RetCam wide-field infant fundus image.
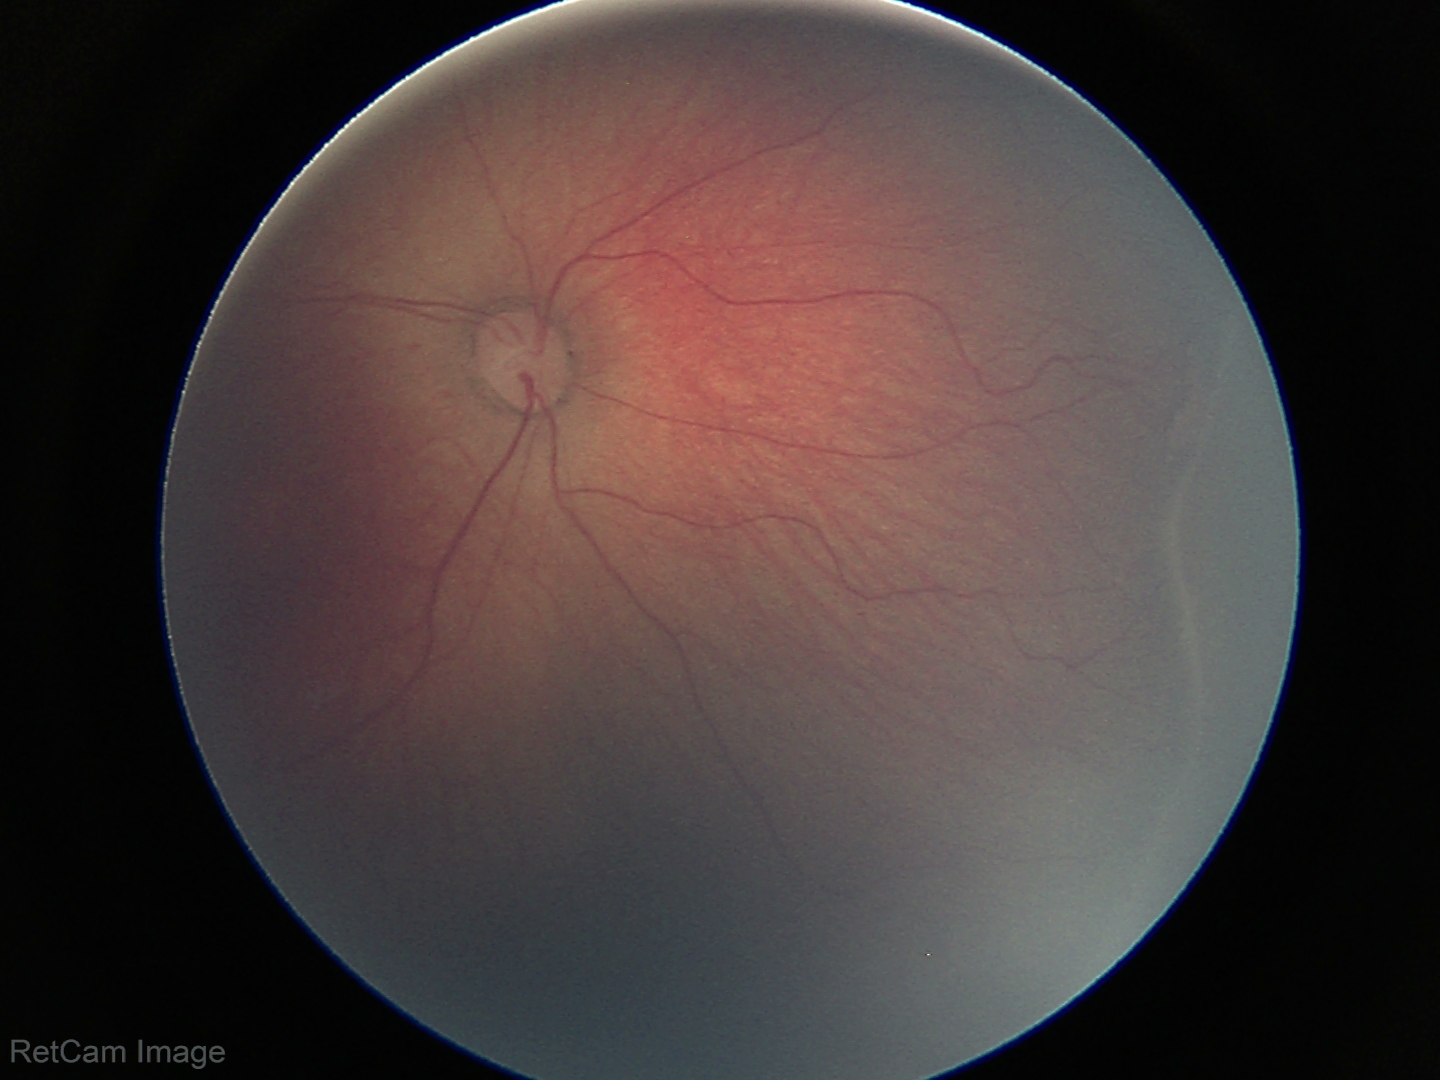
Impression: retinopathy of prematurity (ROP) stage 2 | no plus disease.